Pediatric wide-field fundus photograph
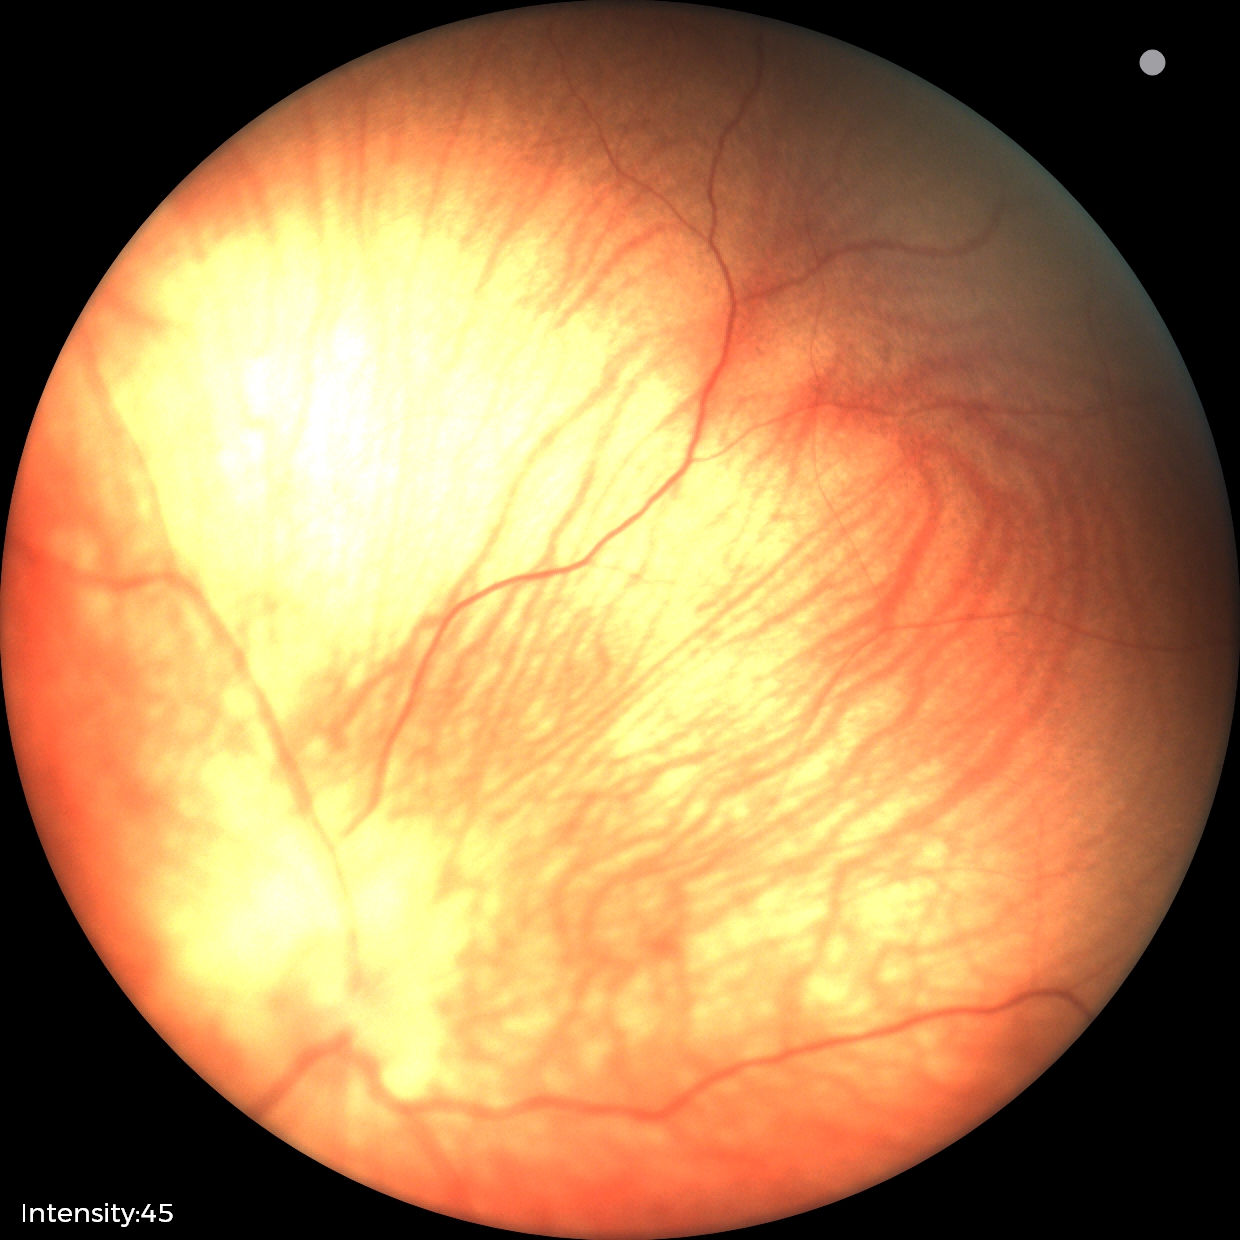 Screening: physiological finding.